Color fundus photograph; 512x512px — 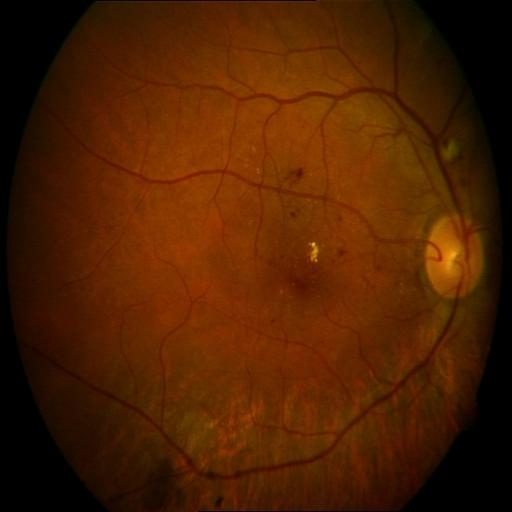
Diagnoses (3): exudation, hemorrhagic retinopathy, myopia.